45° FOV
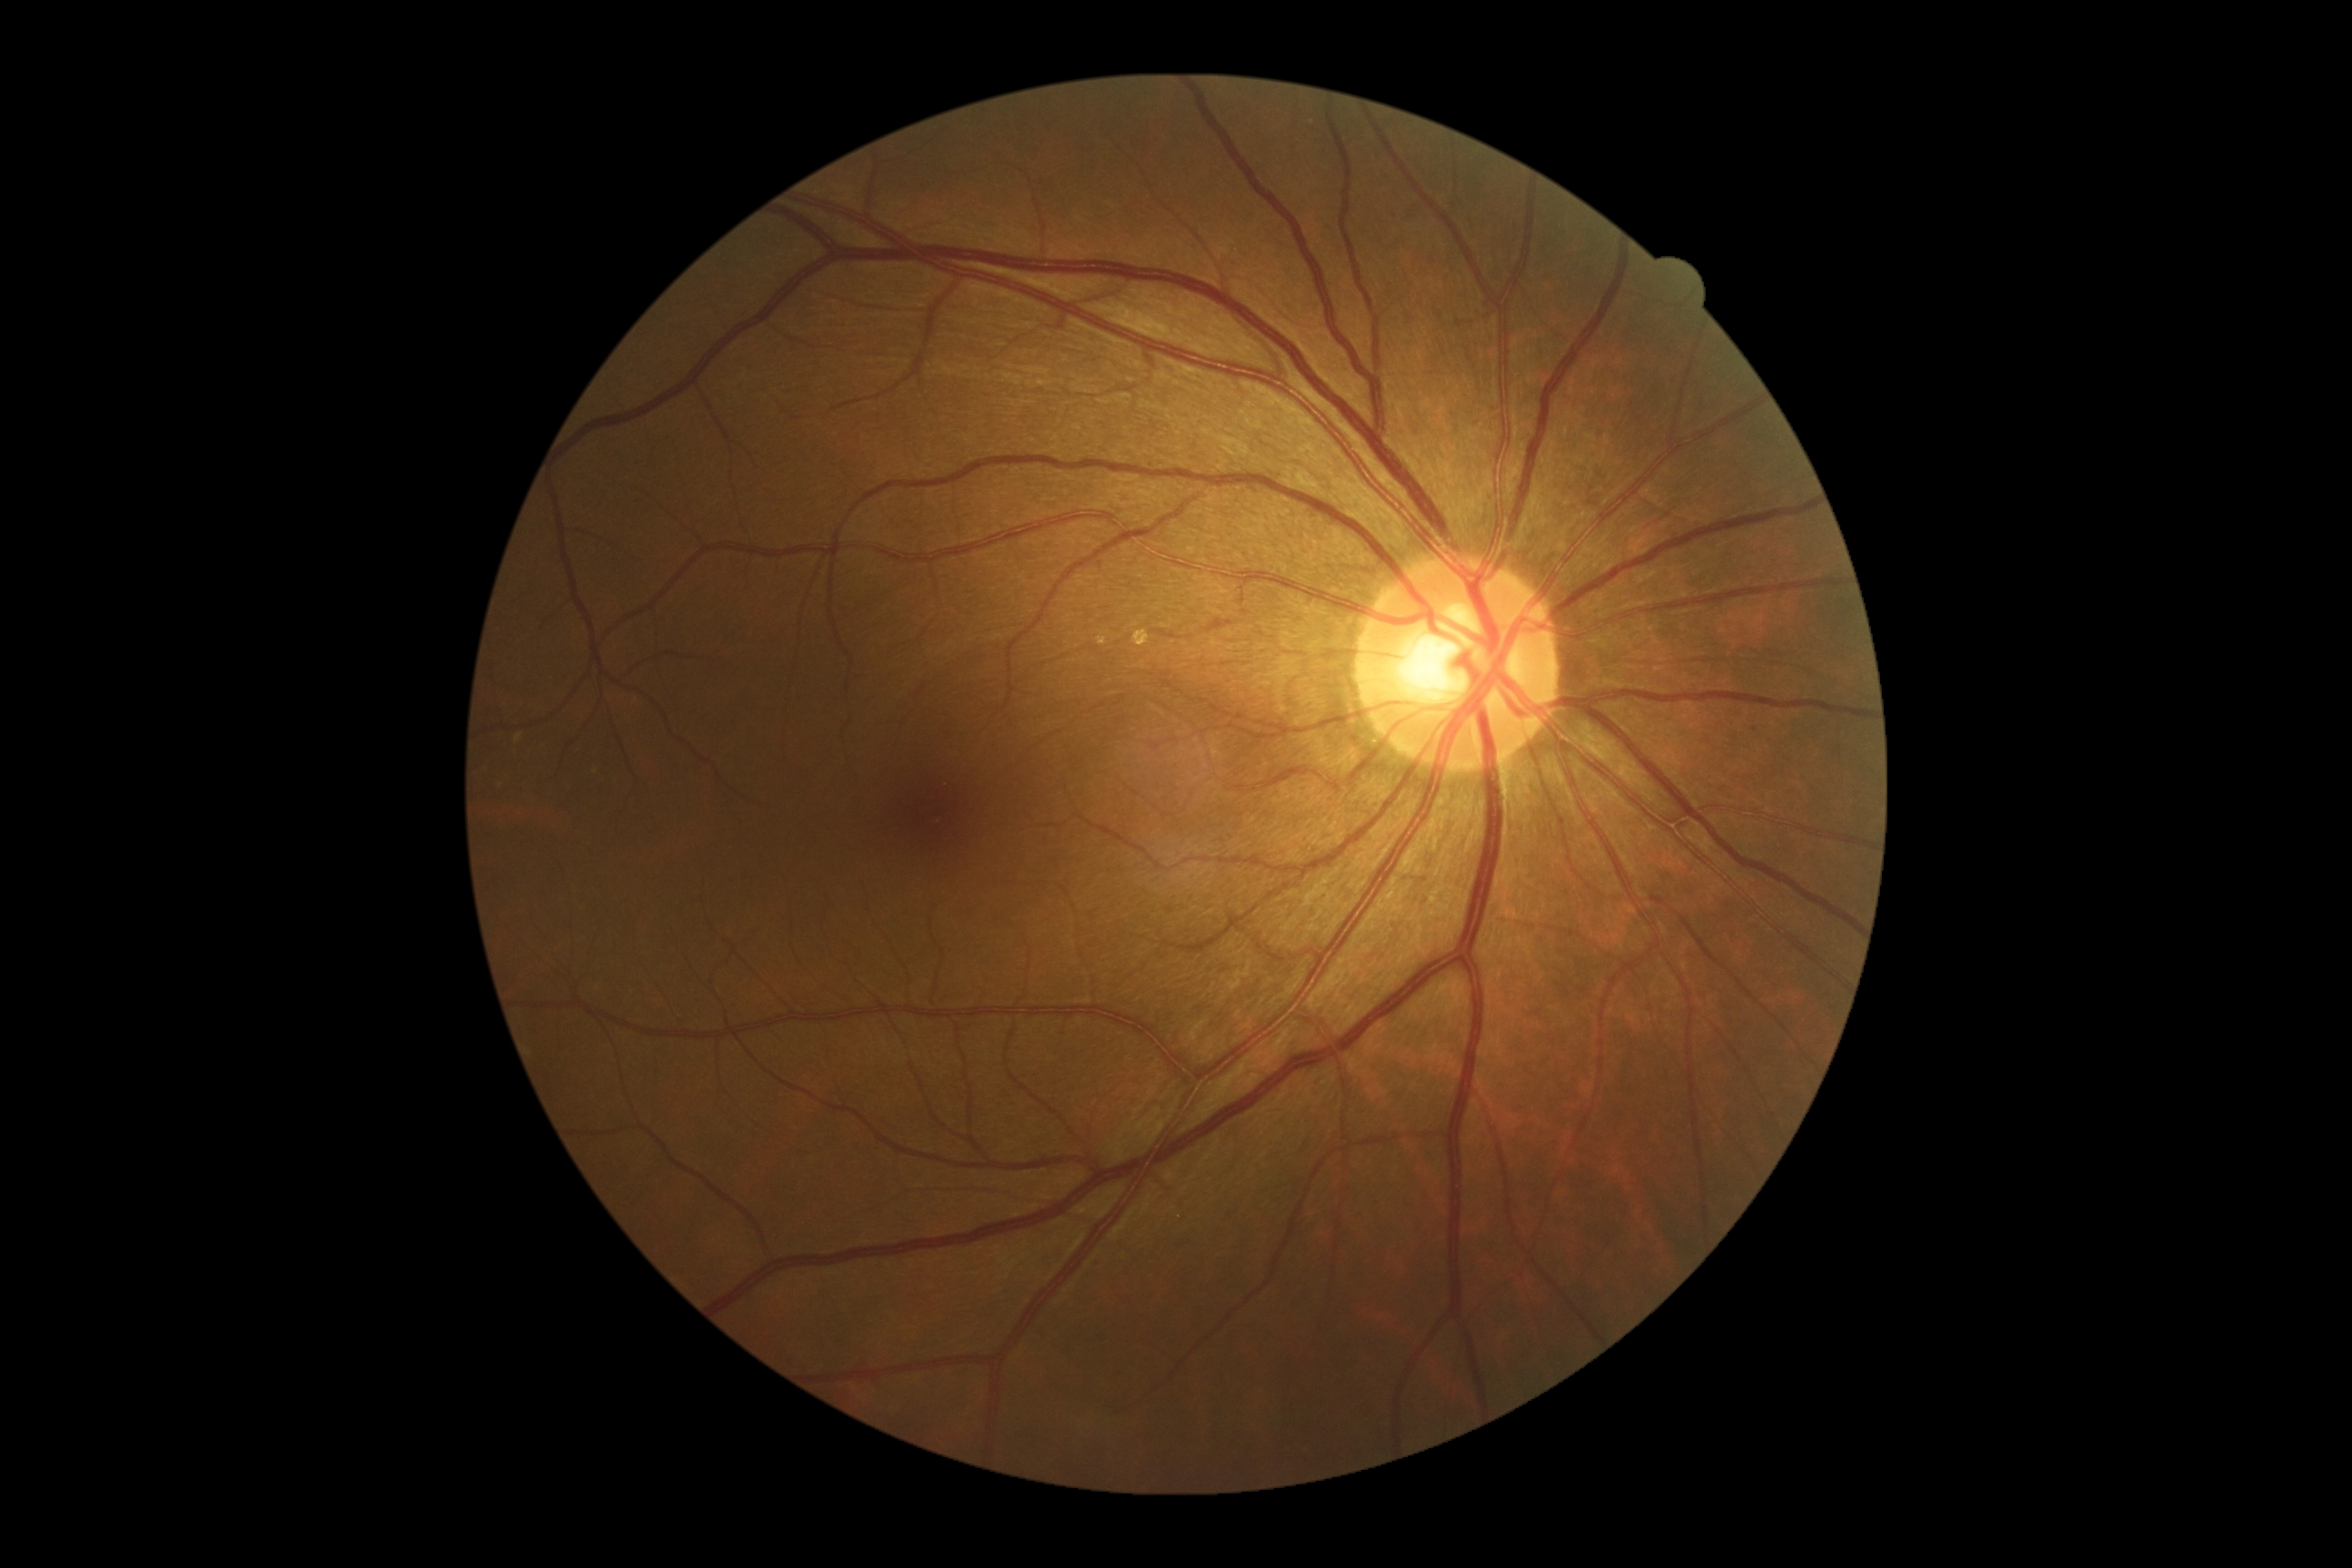 Findings:
* diabetic retinopathy severity: grade 0 (no apparent retinopathy)